Pupil-dilated. Image size 1932x1932:
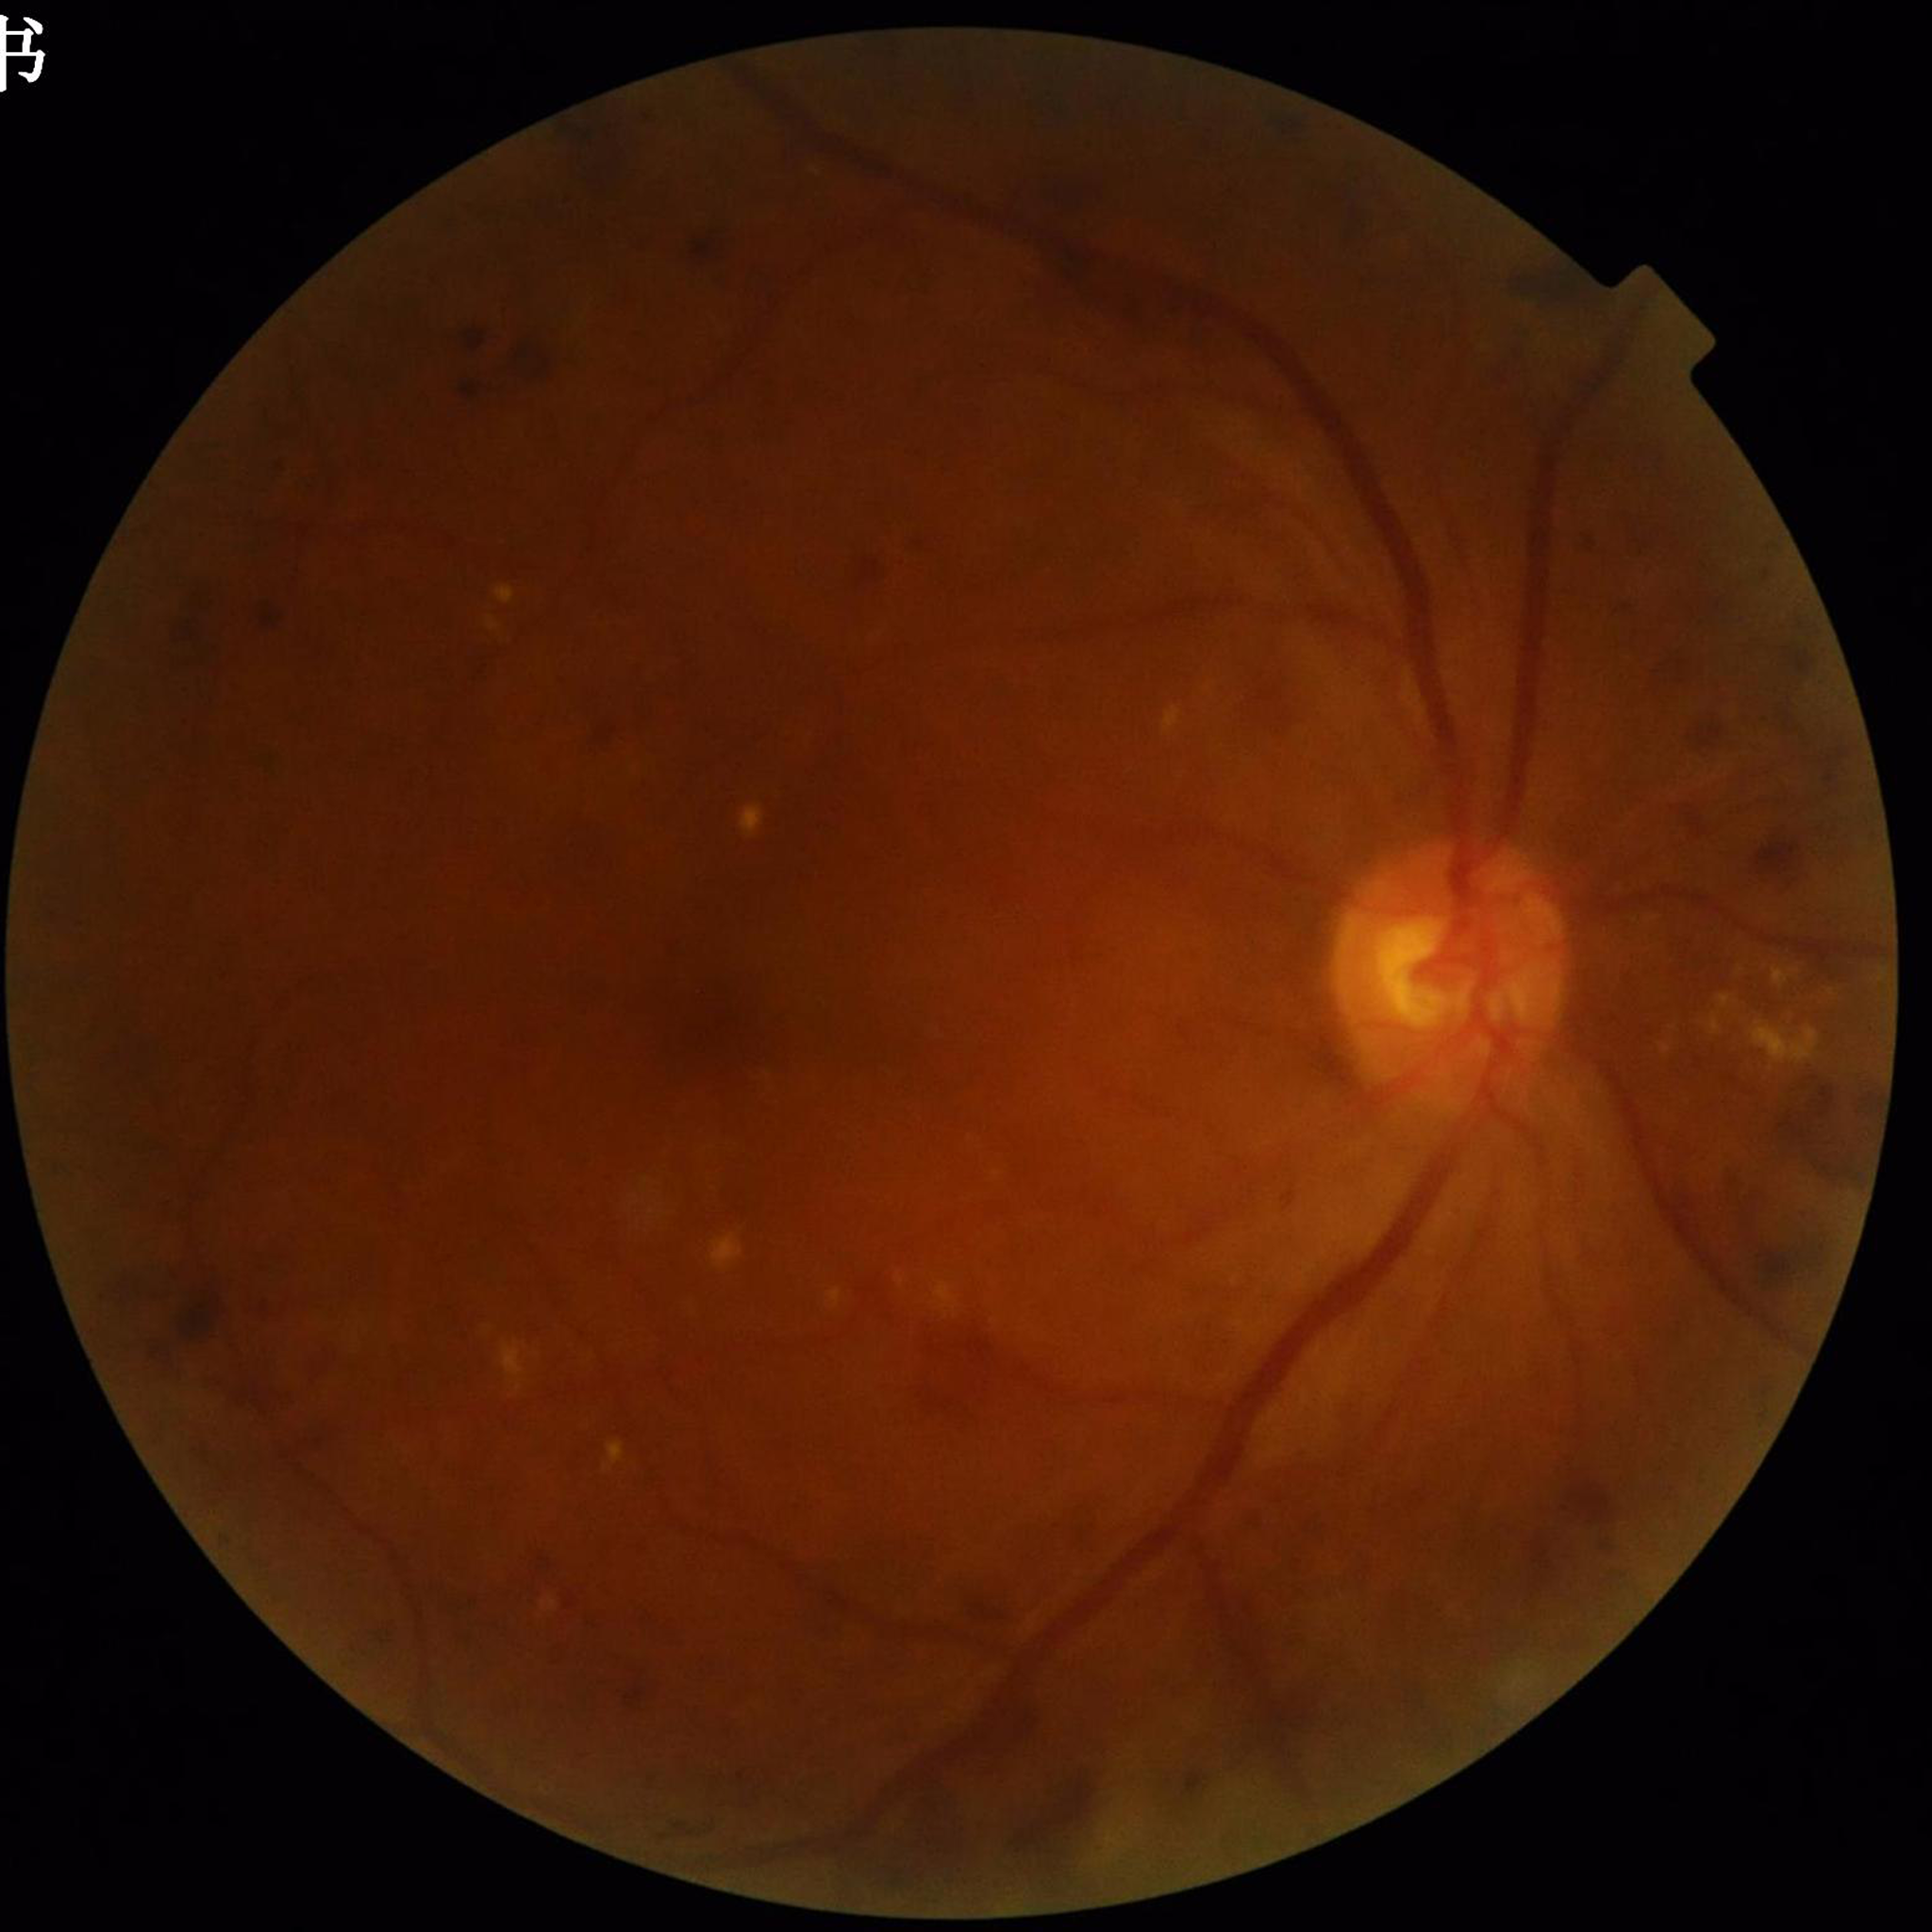

Quality assessment: poor — blur
Disease class: diabetic retinopathy